Pediatric retinal photograph (wide-field) · image size 1240x1240.
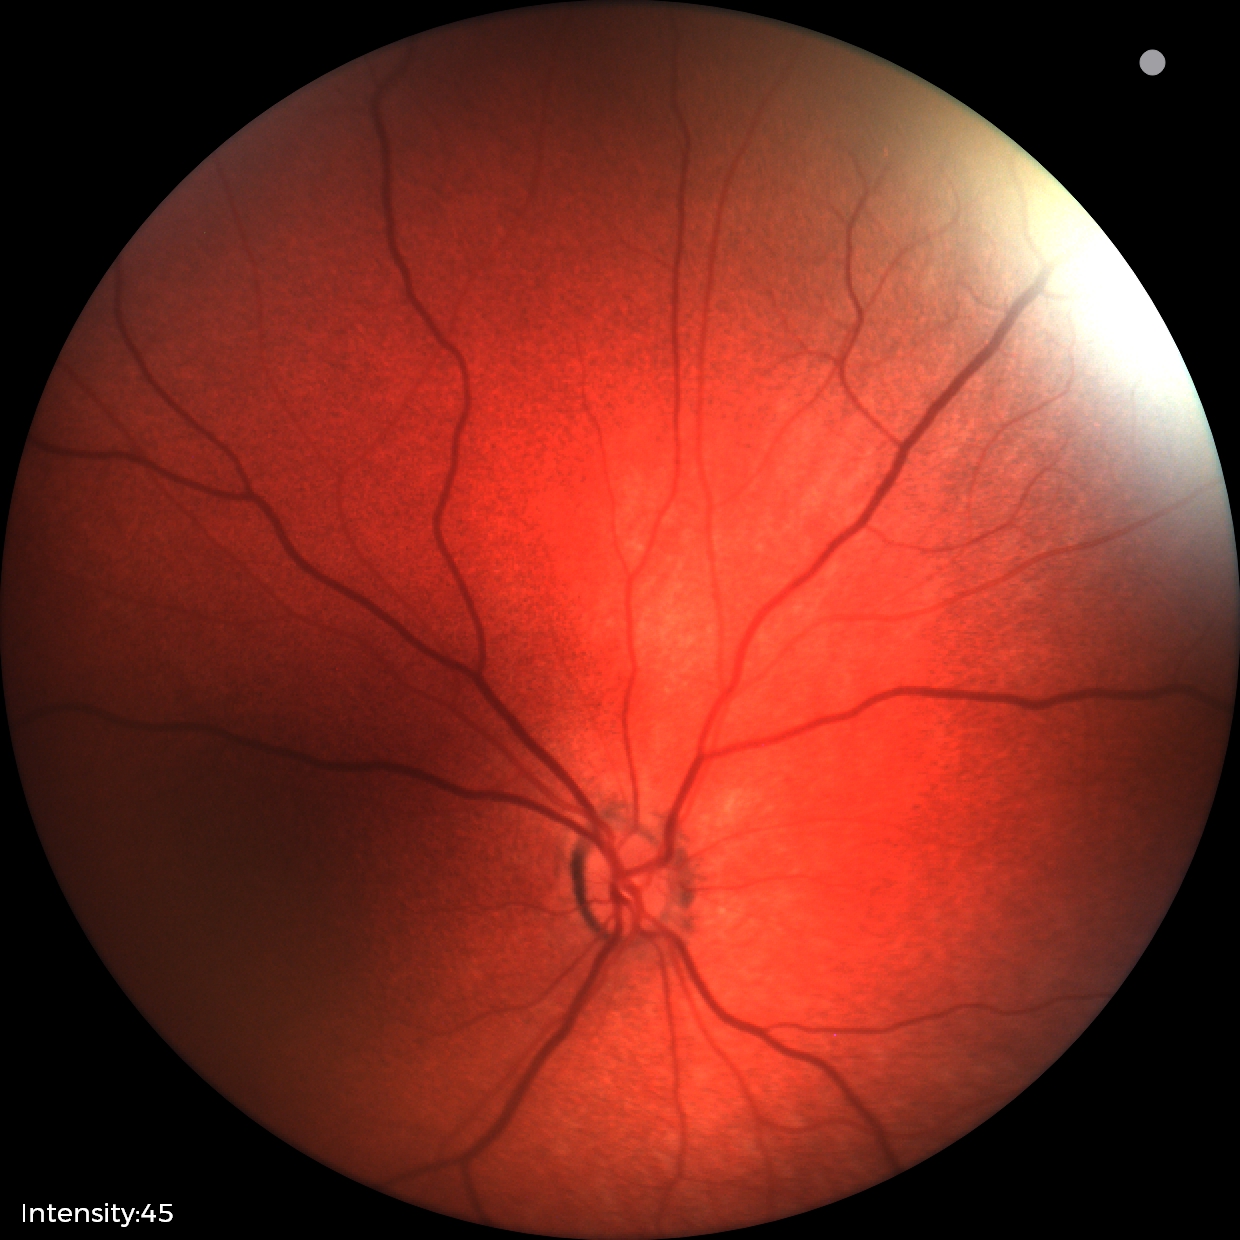 Q: What is the diagnosis from this examination?
A: physiological appearance with no retinal pathology